240x240
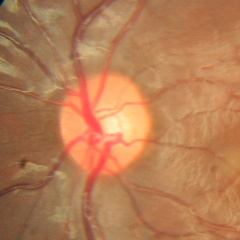
No glaucomatous changes.